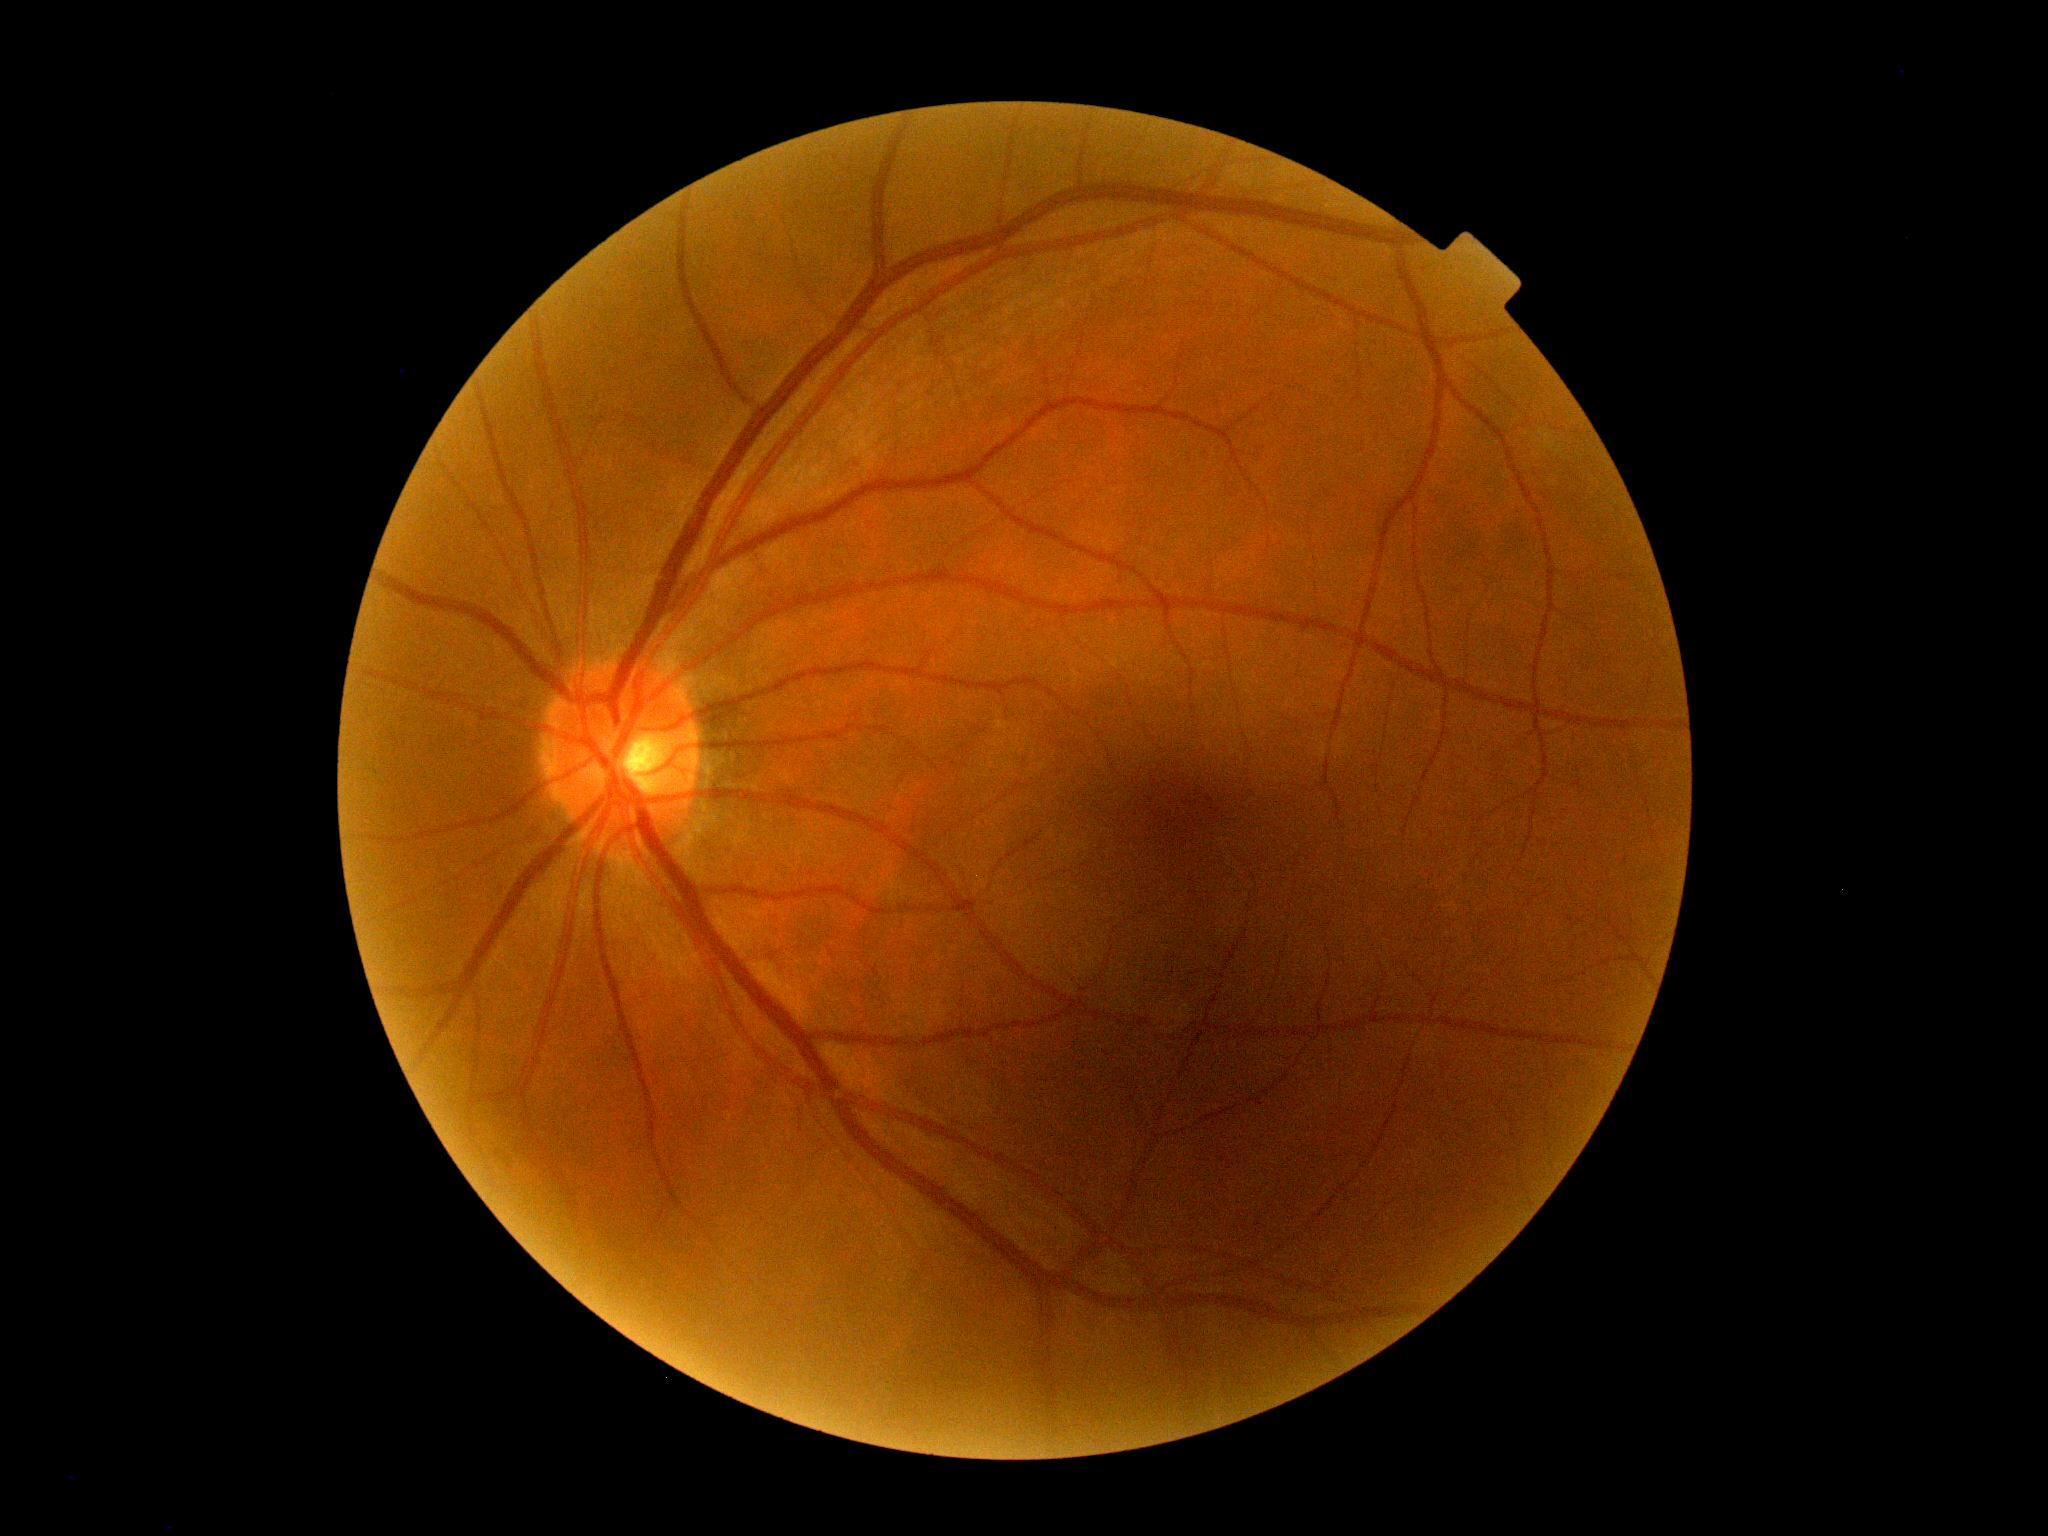

Diabetic retinopathy (DR) is grade 0.